1240 x 1240 pixels; pediatric retinal photograph (wide-field); camera: Phoenix ICON (100° FOV)
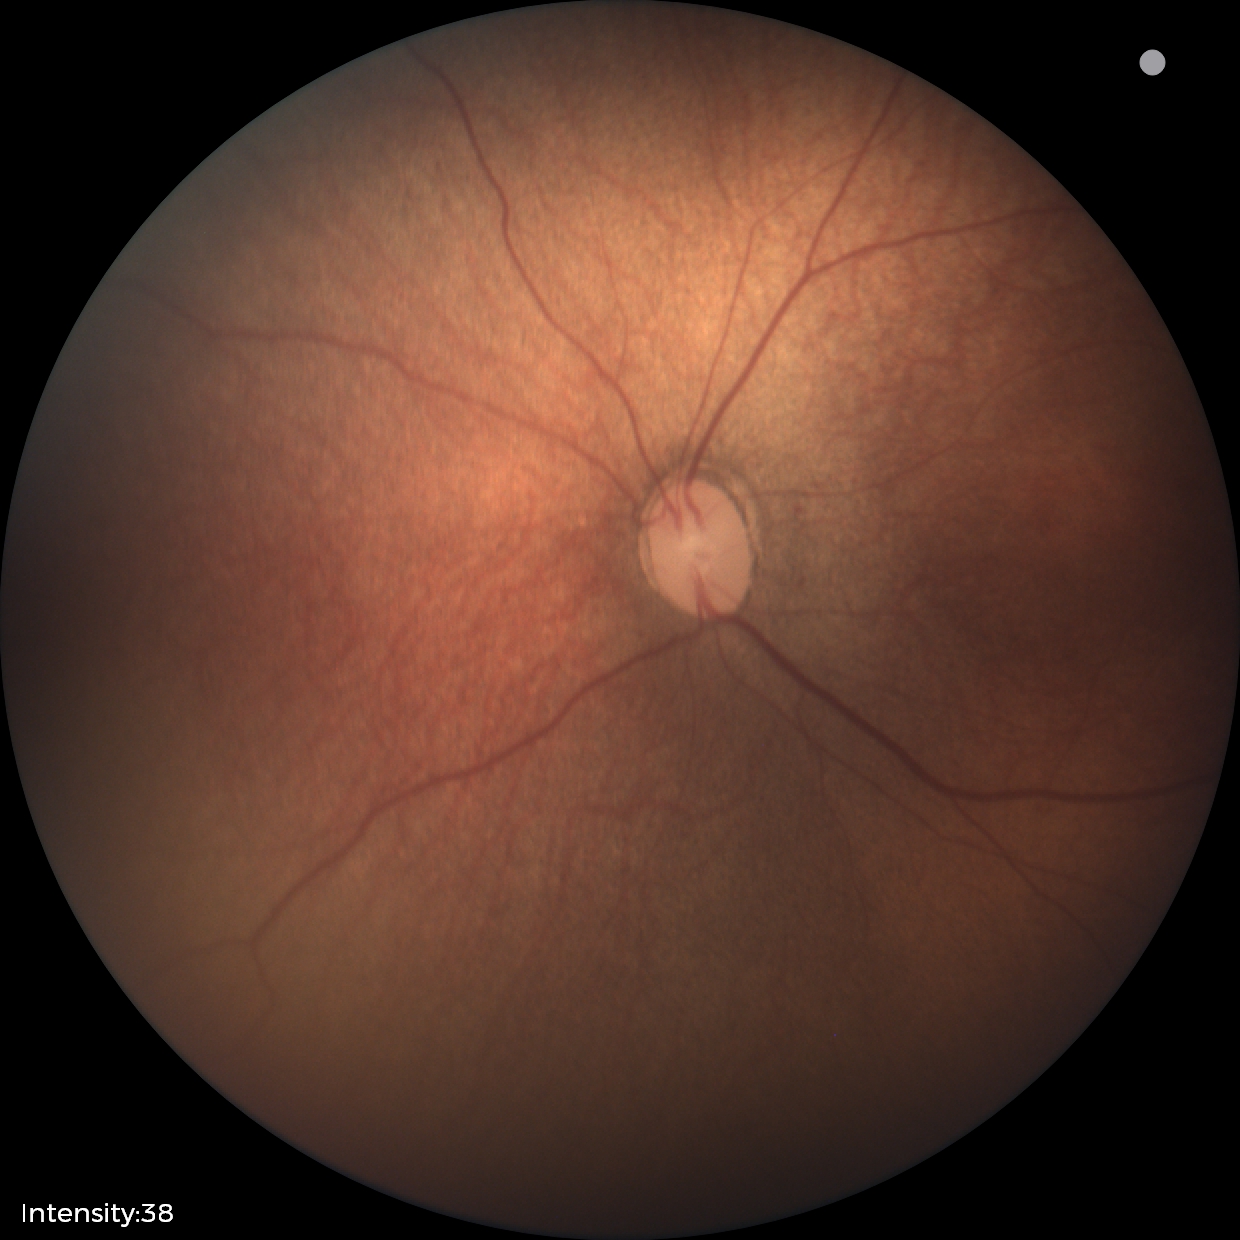
Diagnosis from this screening exam: status post retinopathy of prematurity.
Without plus disease.